FOV: 45 degrees, 2352 by 1568 pixels, CFP
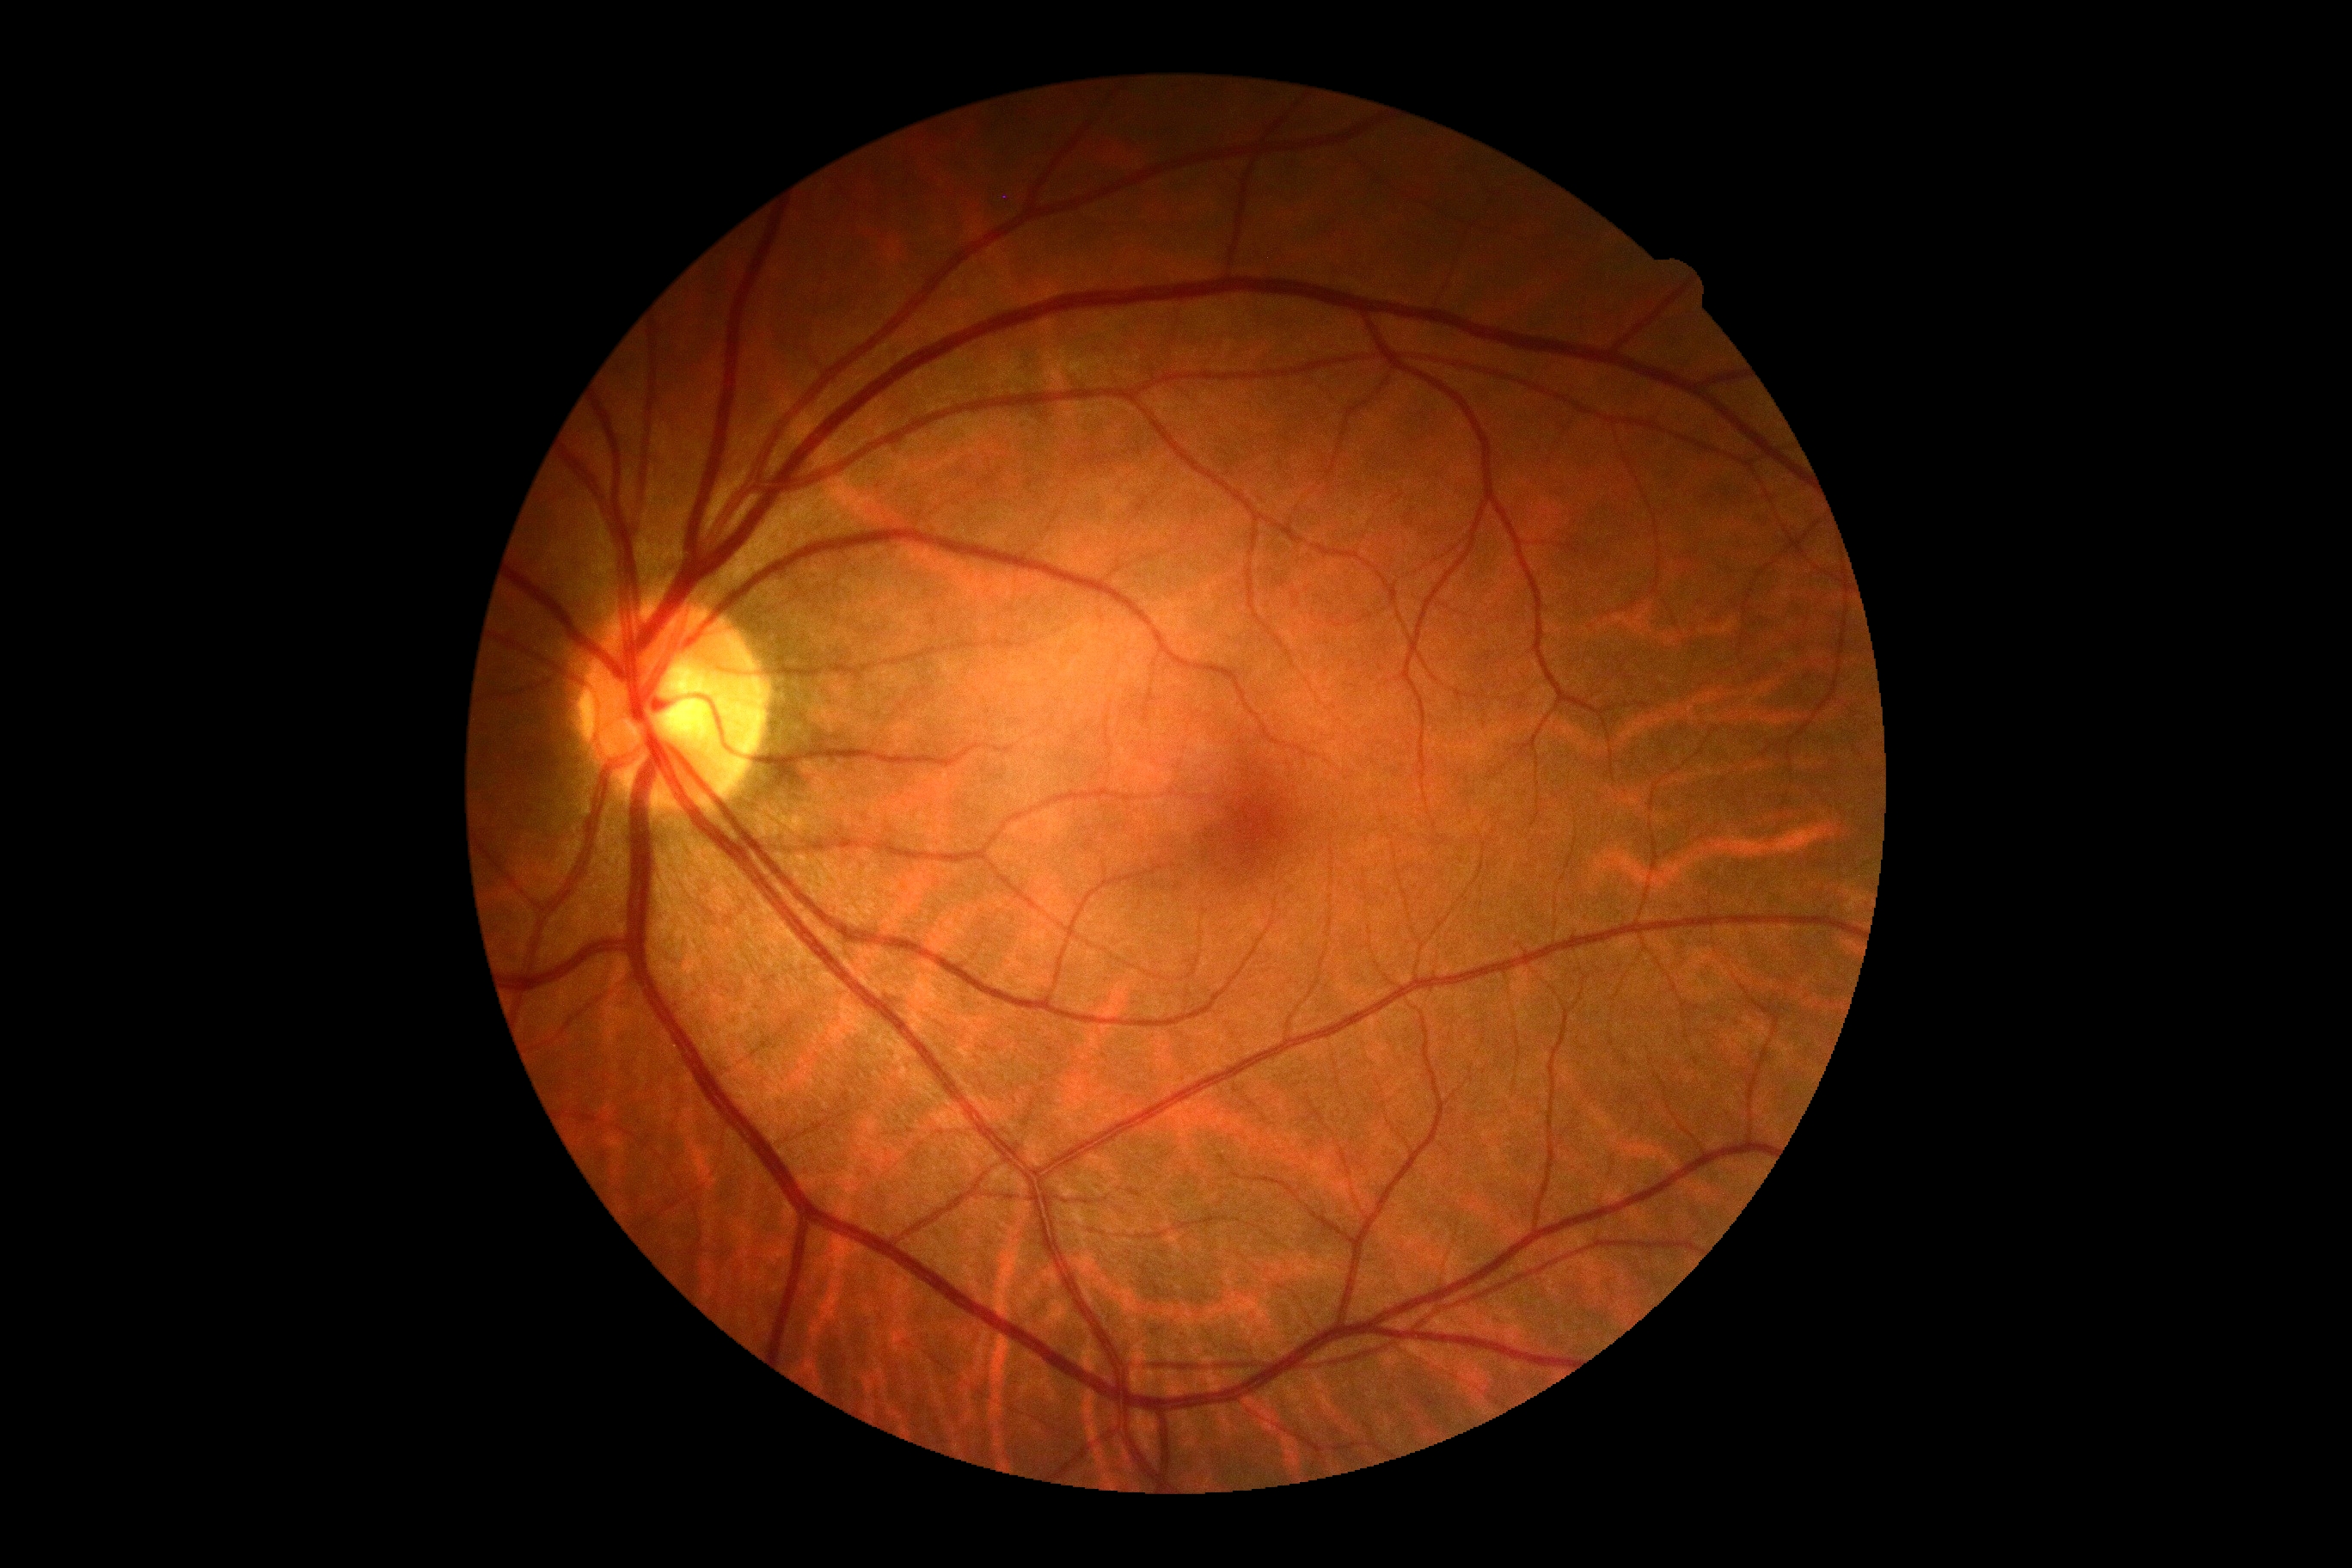

DR grade: 0/4 — no visible signs of diabetic retinopathy.